Ultra-widefield fundus mosaic — 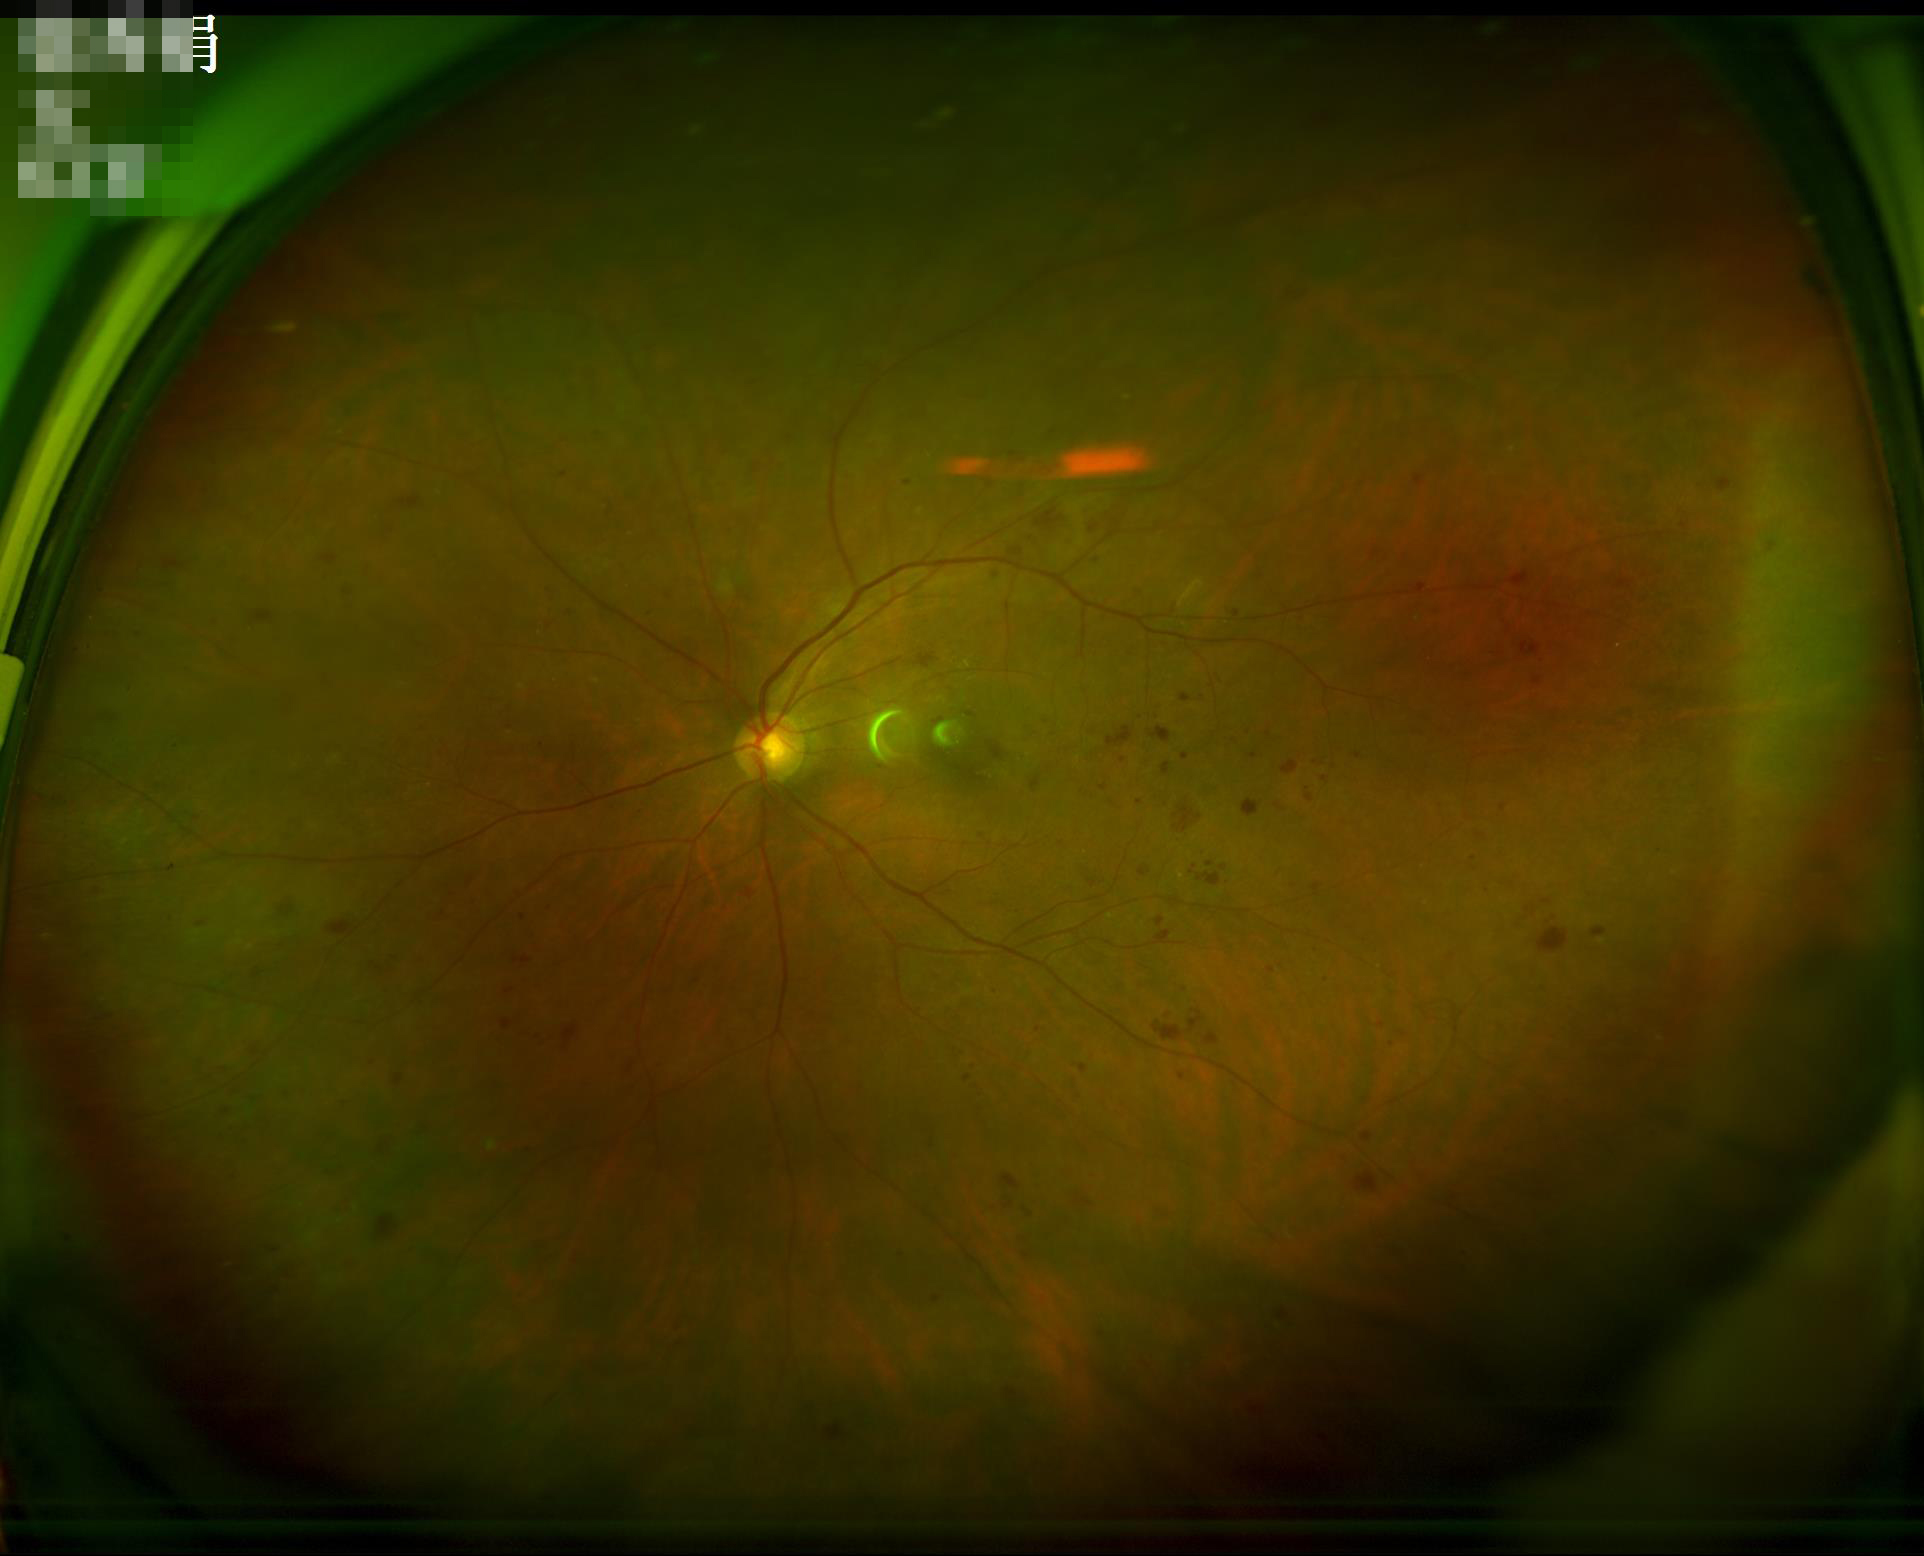 {
  "overall_quality": "good",
  "clarity": "sharp",
  "contrast": "good",
  "illumination": "adequate"
}